Captured after pupil dilation:
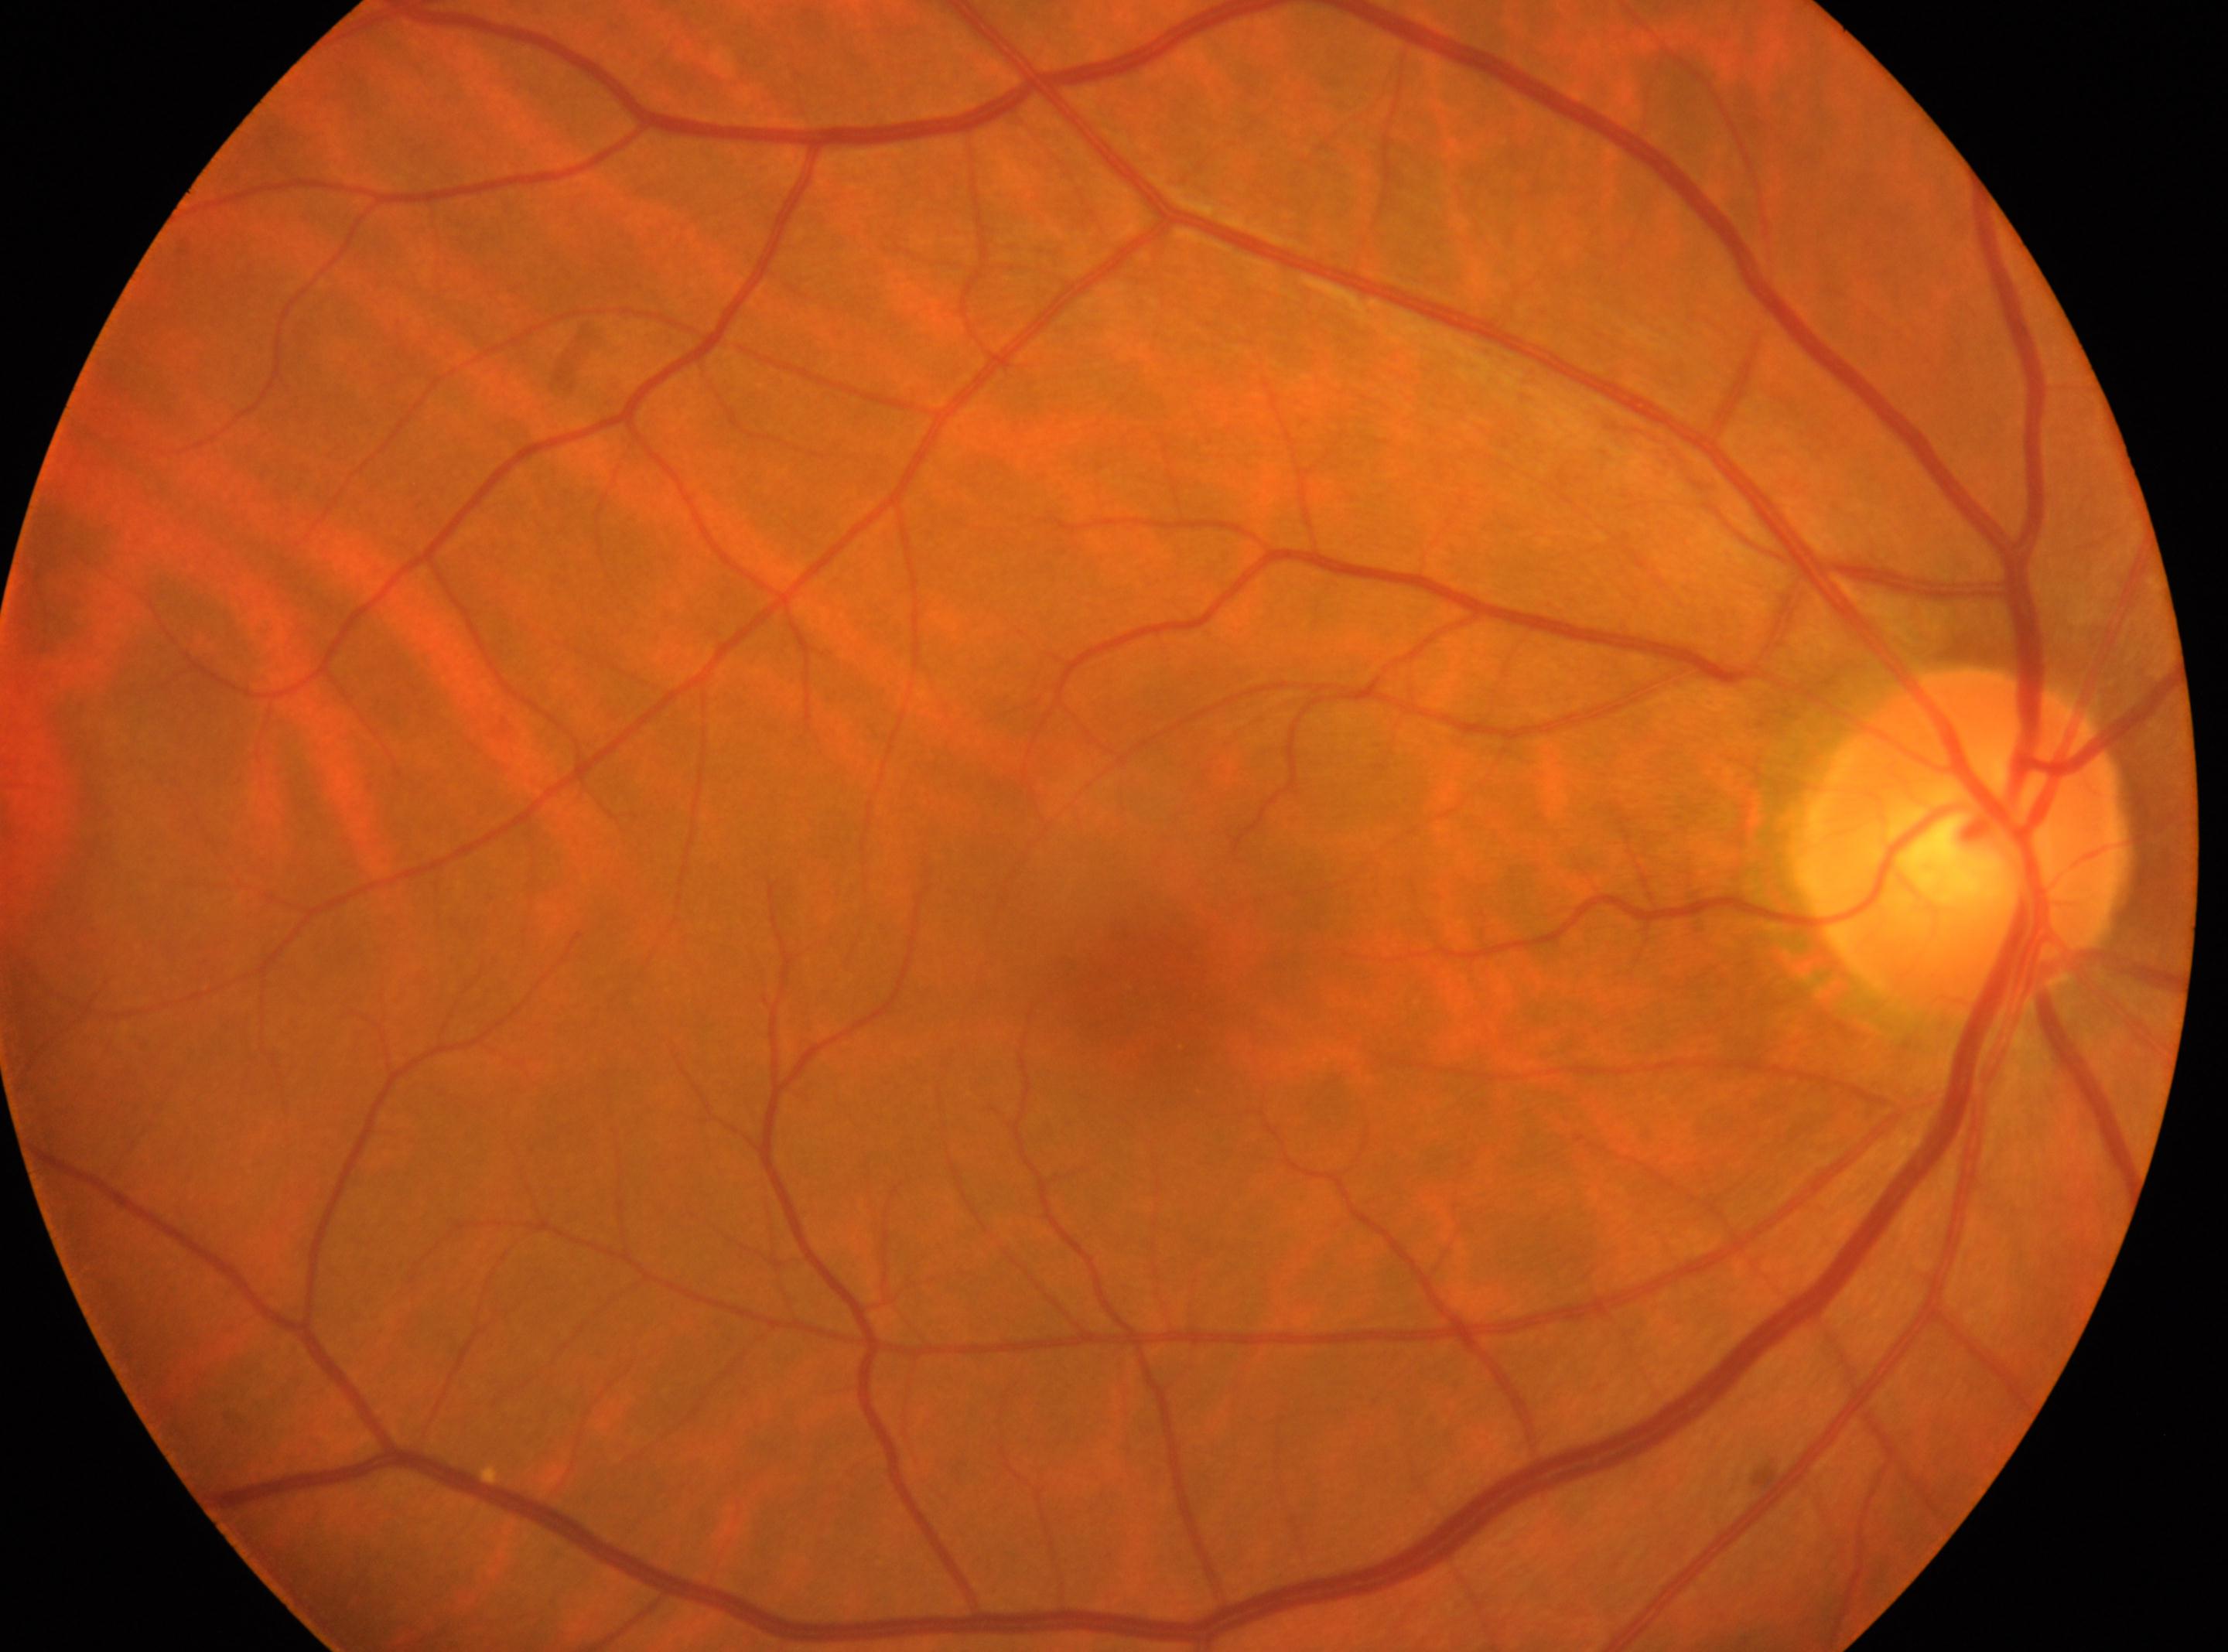 Annotations:
– optic nerve head · 1963px, 840px
– diabetic retinopathy (DR) · no apparent retinopathy (grade 0)
– macula center · 1134px, 978px
– laterality · right eye